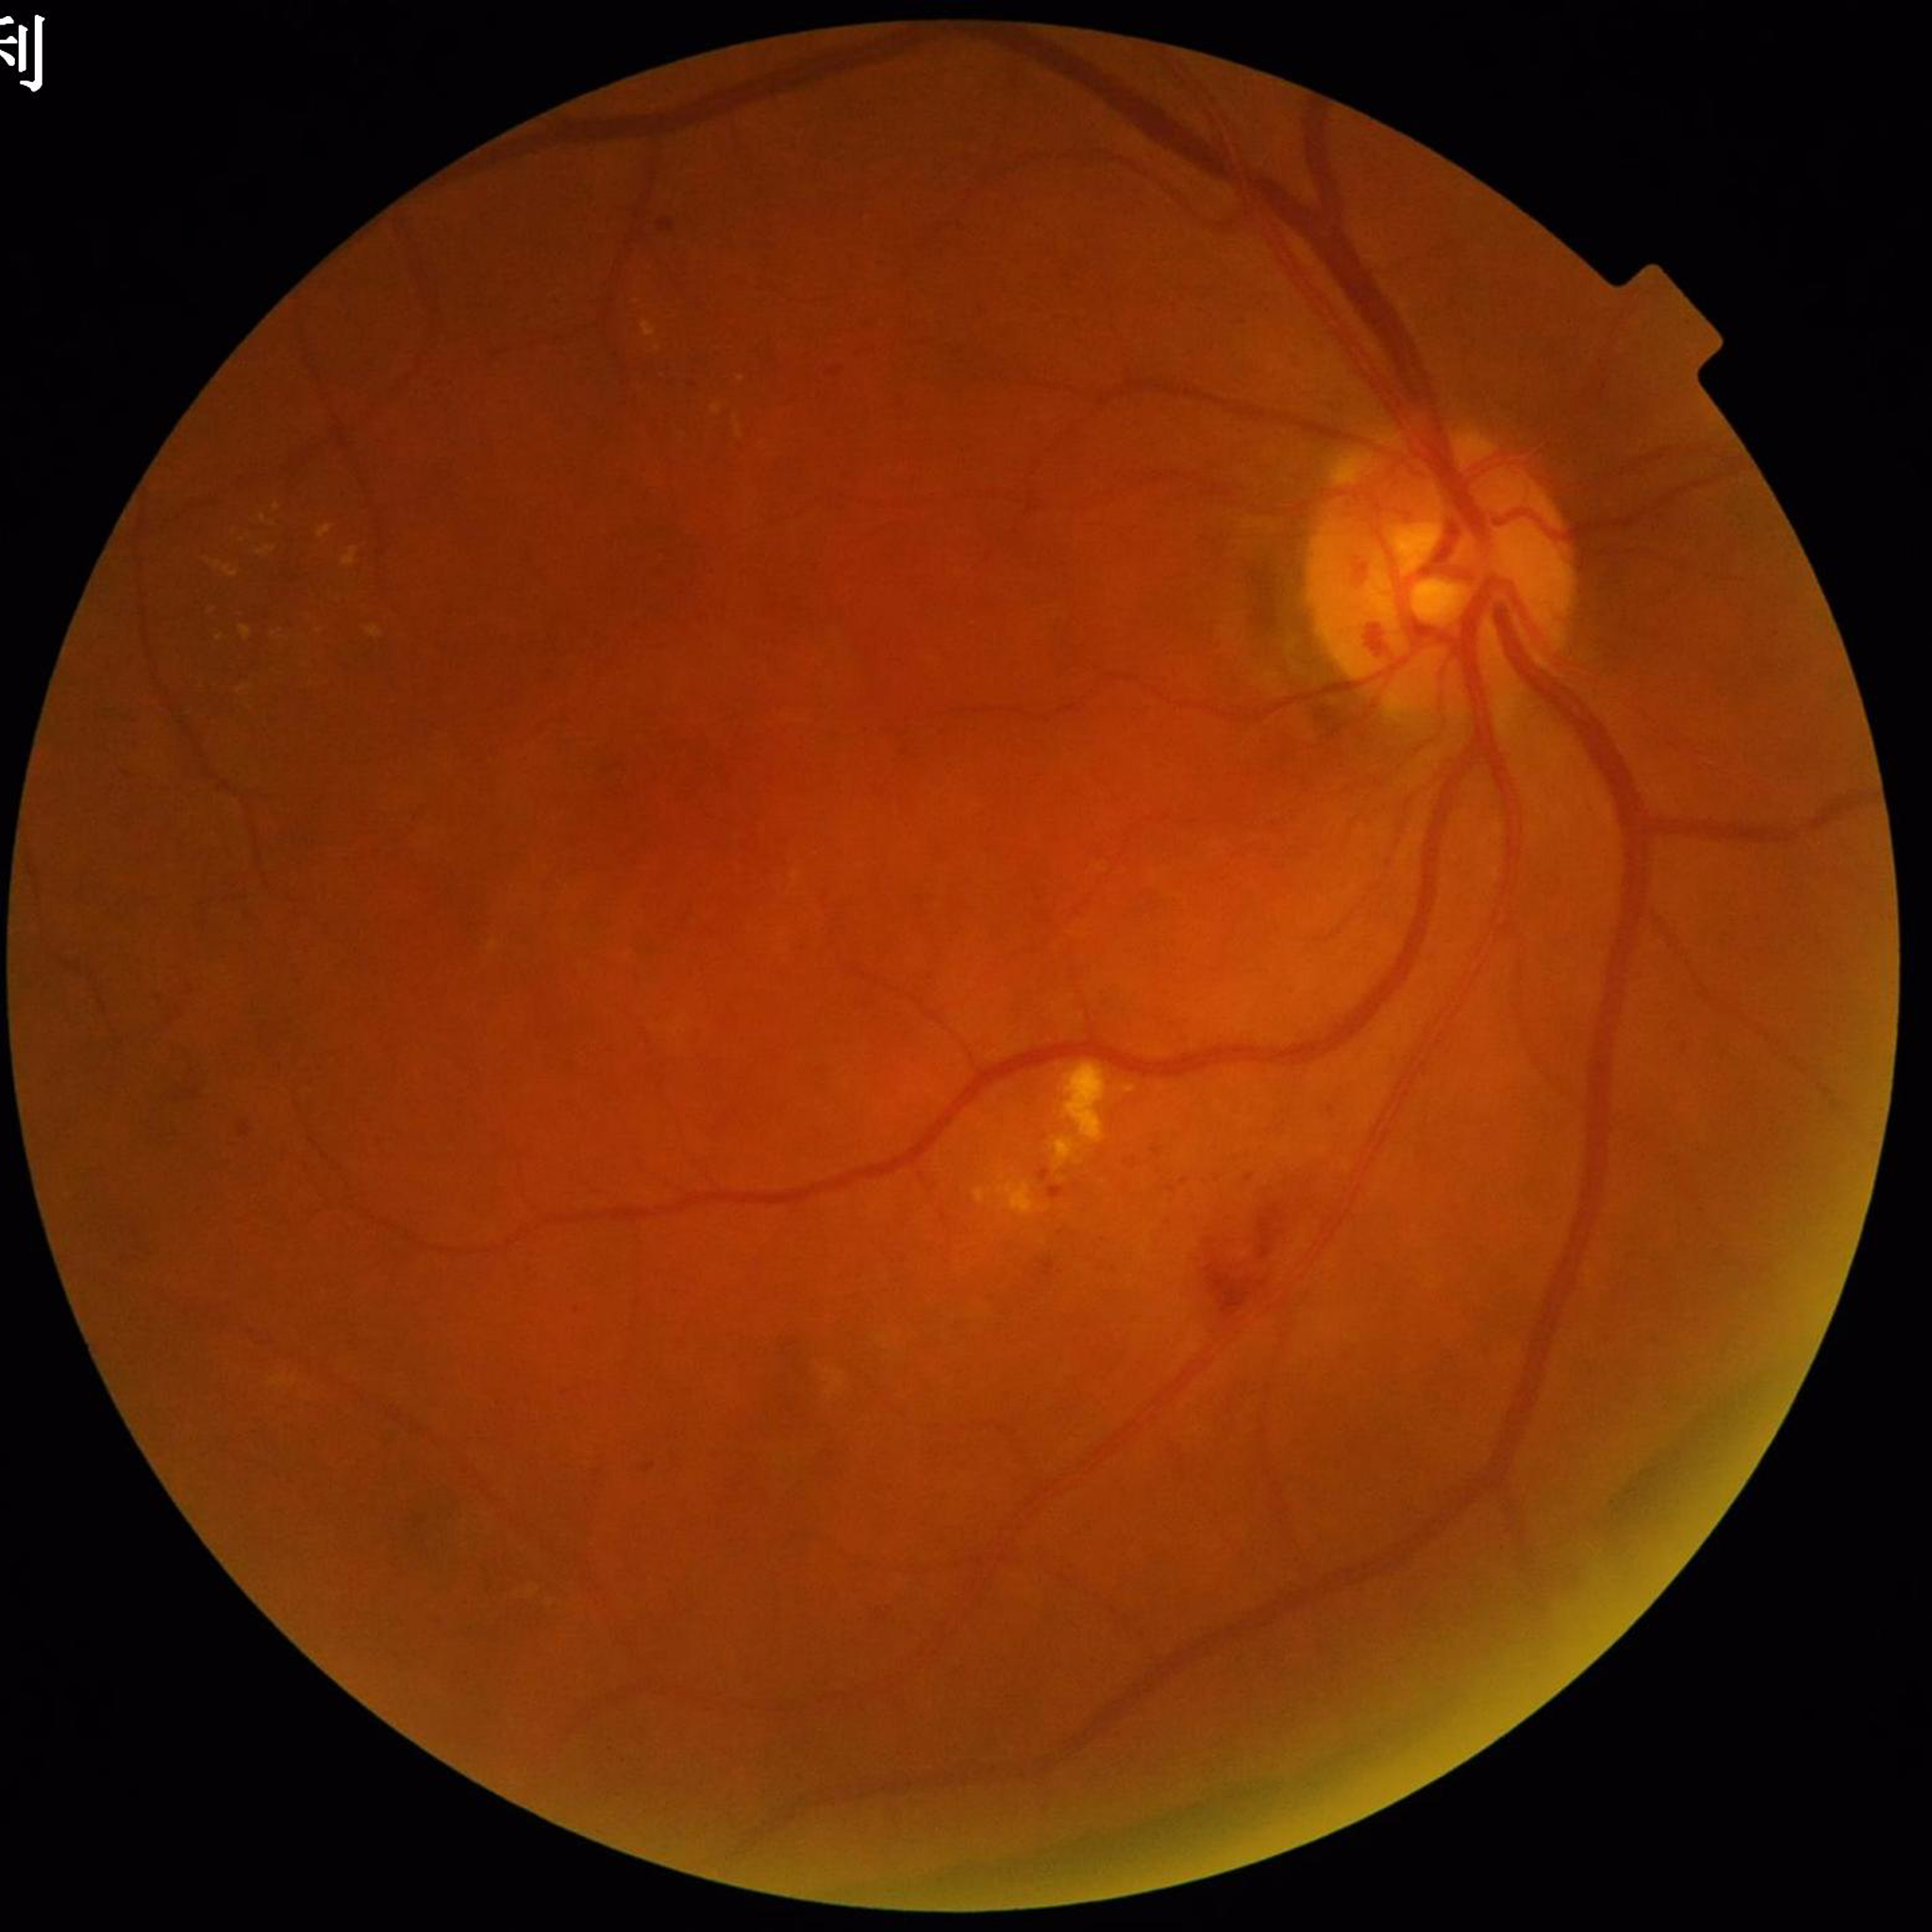
Impression: diabetic retinopathy (DR)